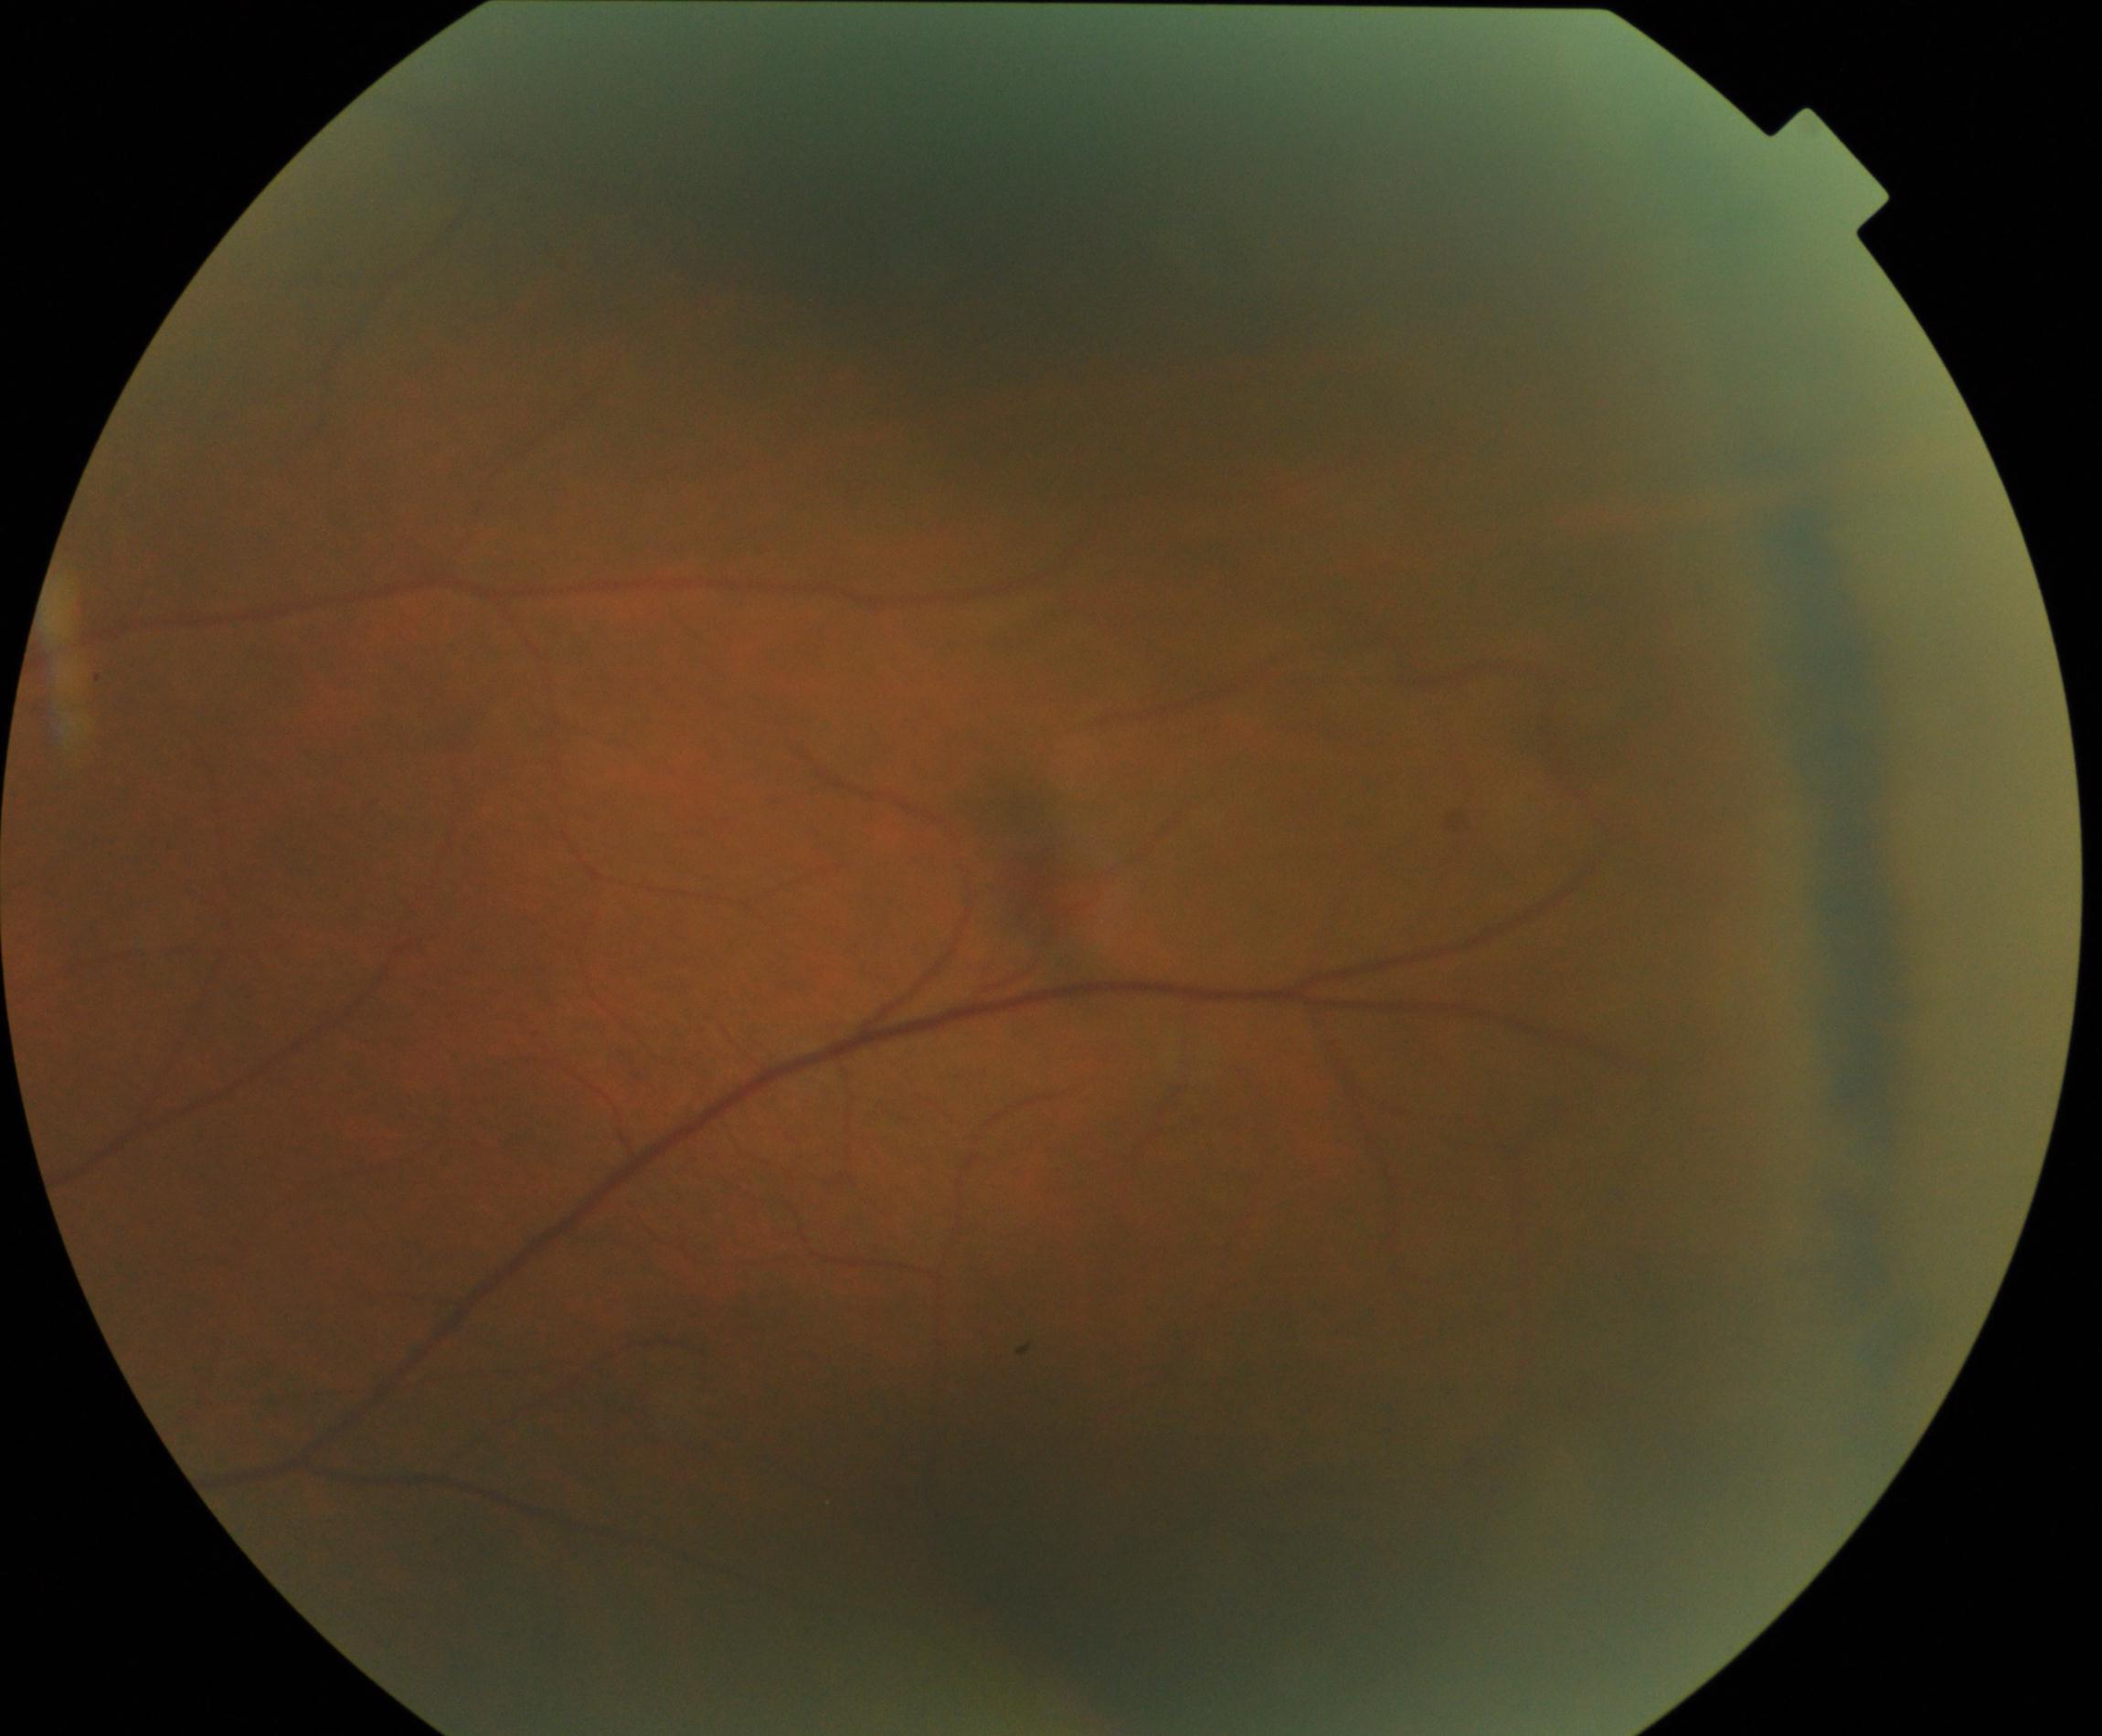 Primary finding: peripheral retinal degeneration and break.